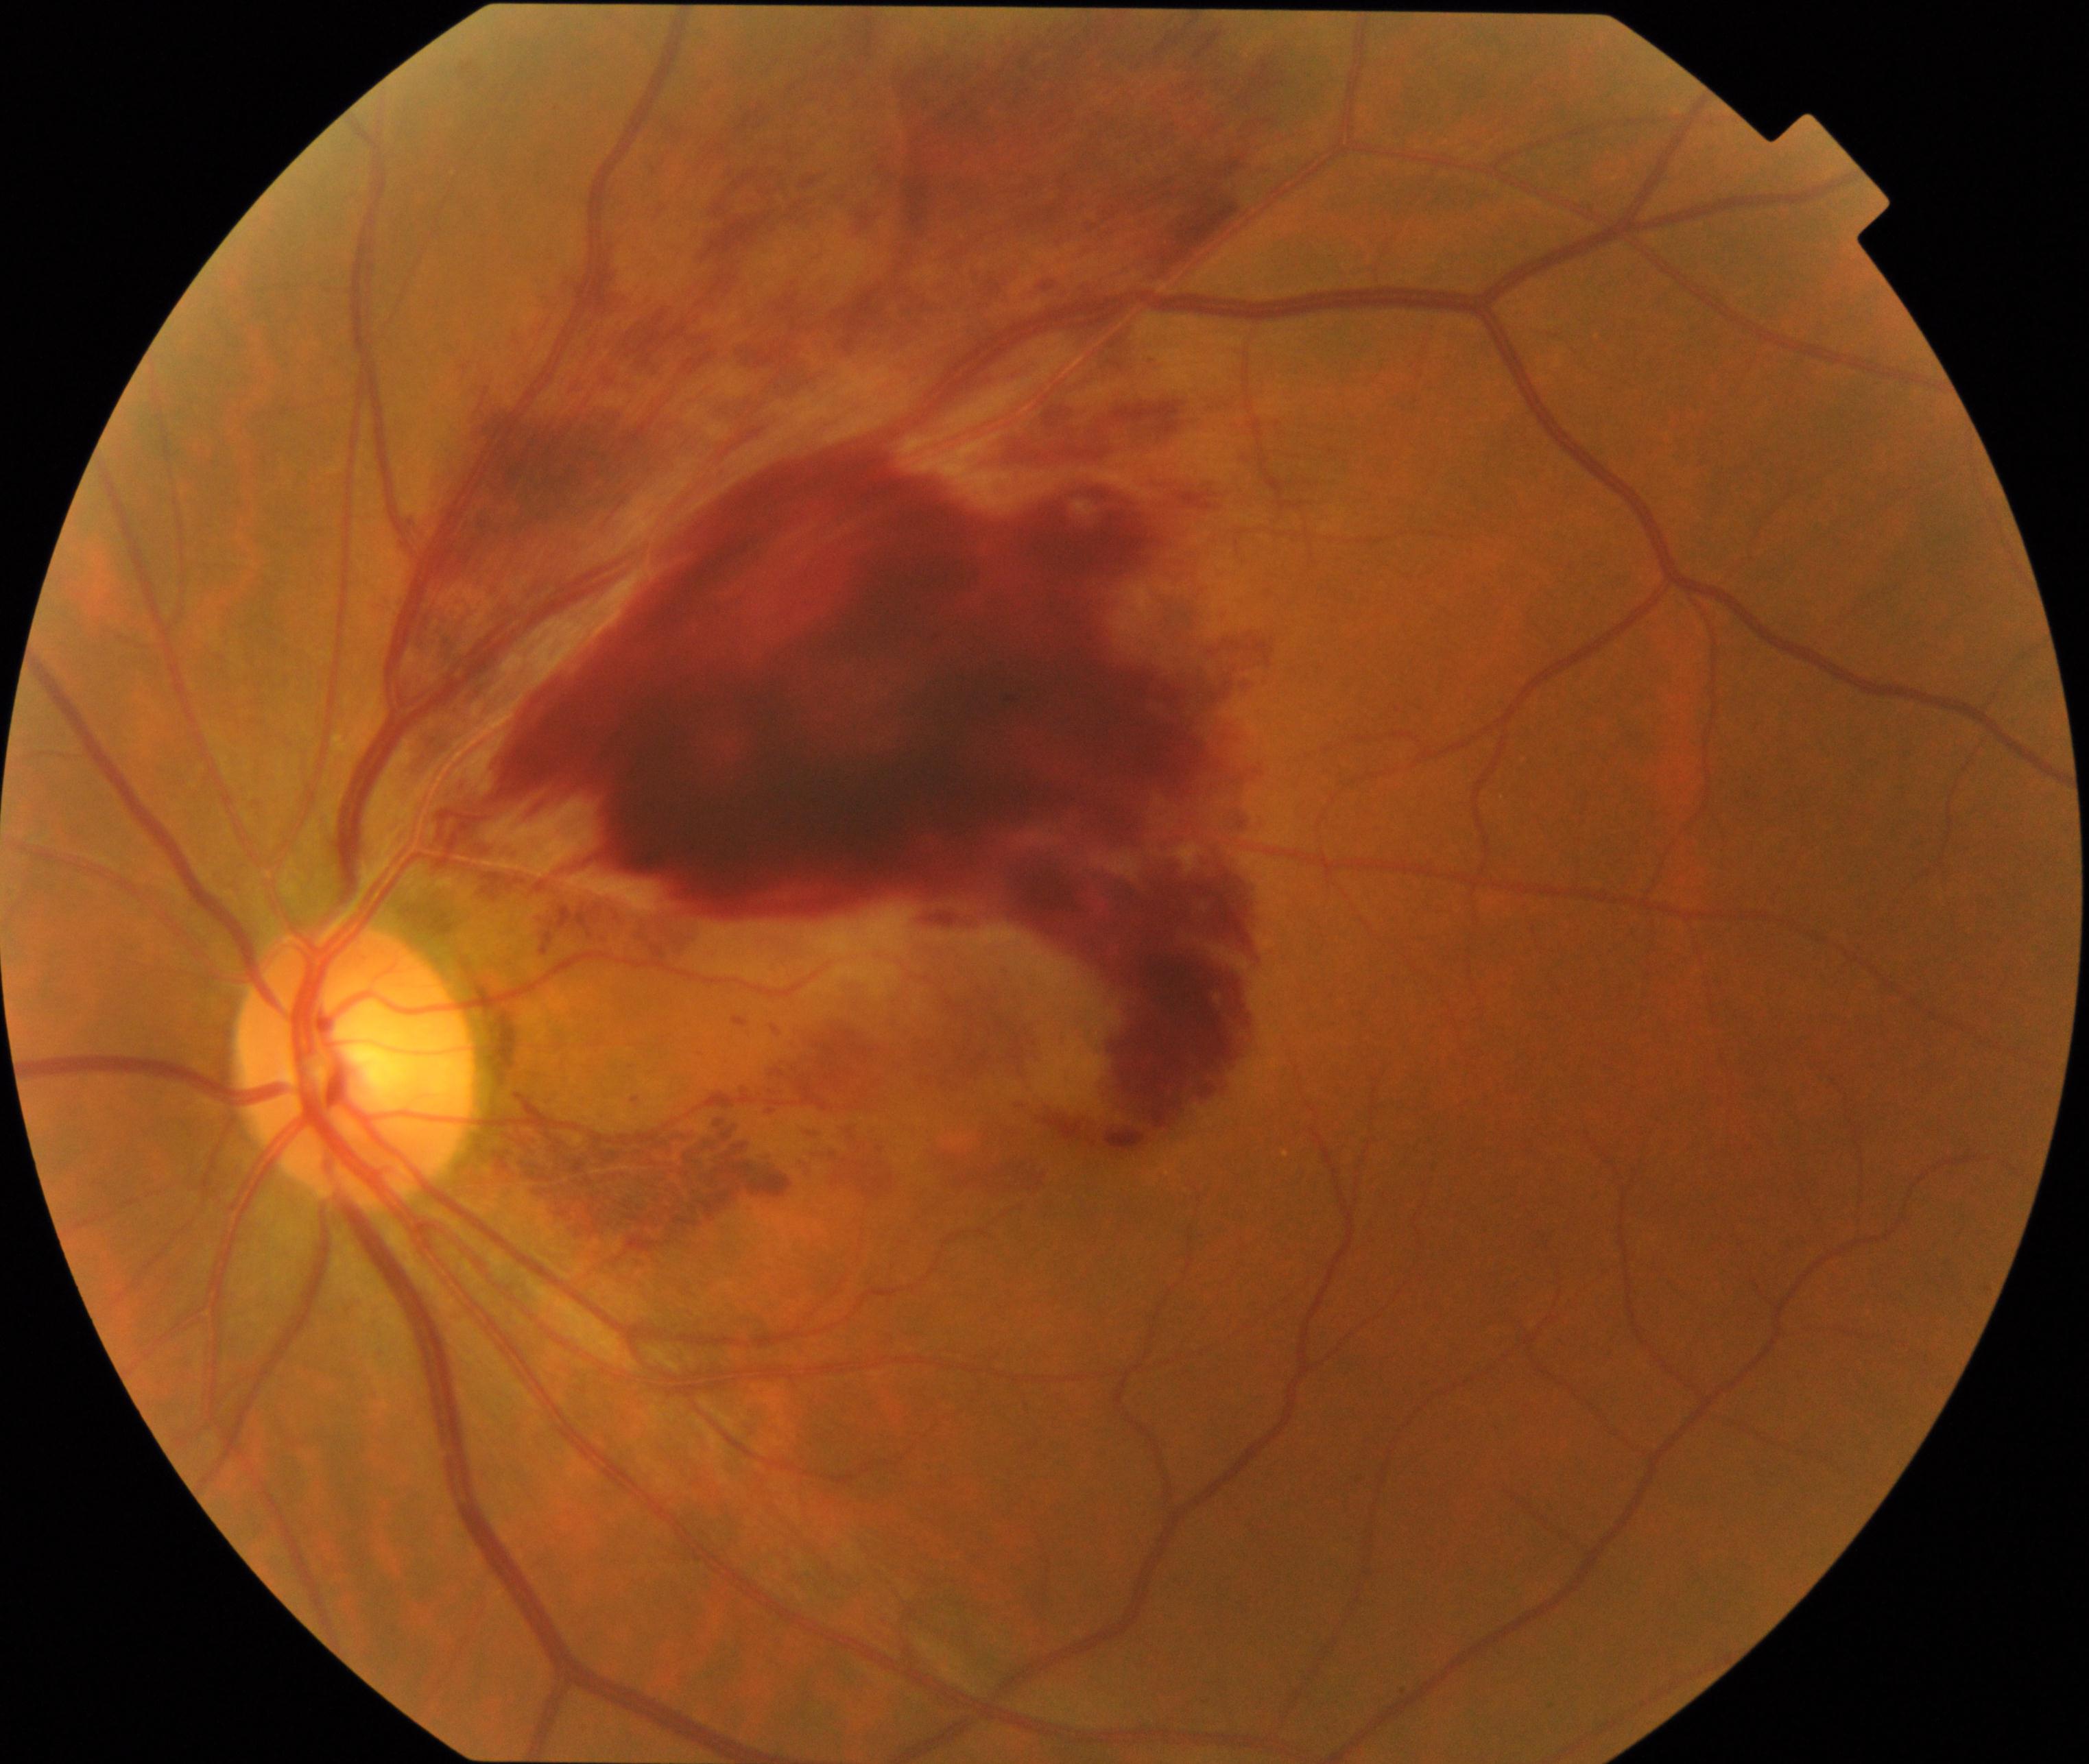 Impression: branch retinal vein occlusion. Typically showing tortuosity and dilatation of affected veins, with dot, blot, and flame hemorrhages, sometimes with cotton-wool spots or hard exudates.